45° FOV, fundus photo, acquired with a NIDEK AFC-230:
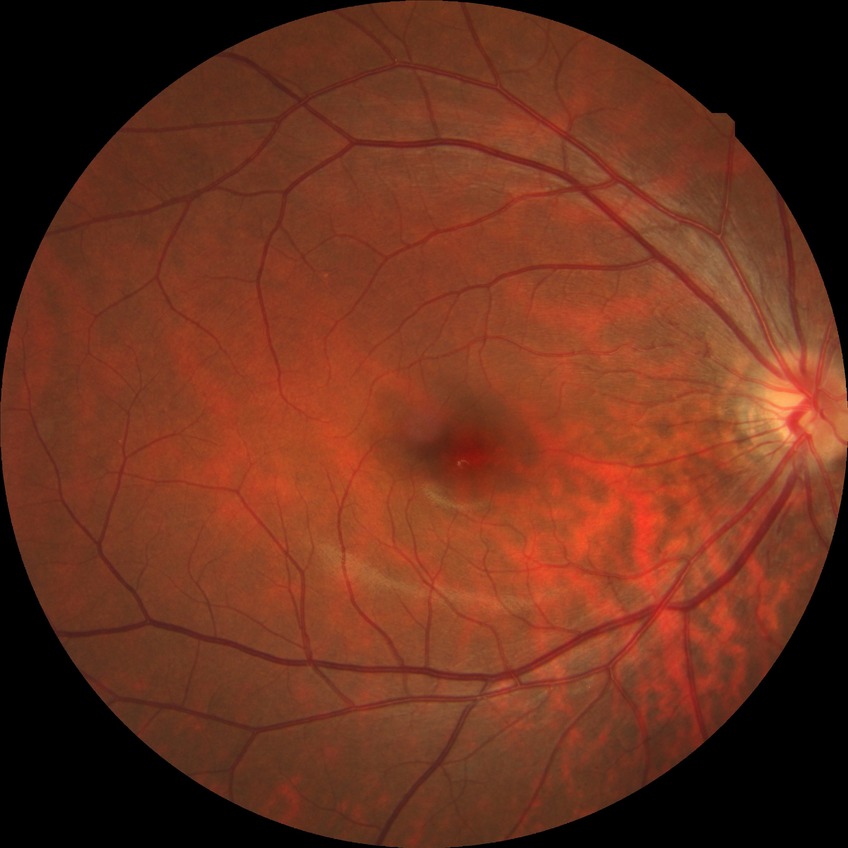
{"davis_grade": "NDR (no diabetic retinopathy)"}